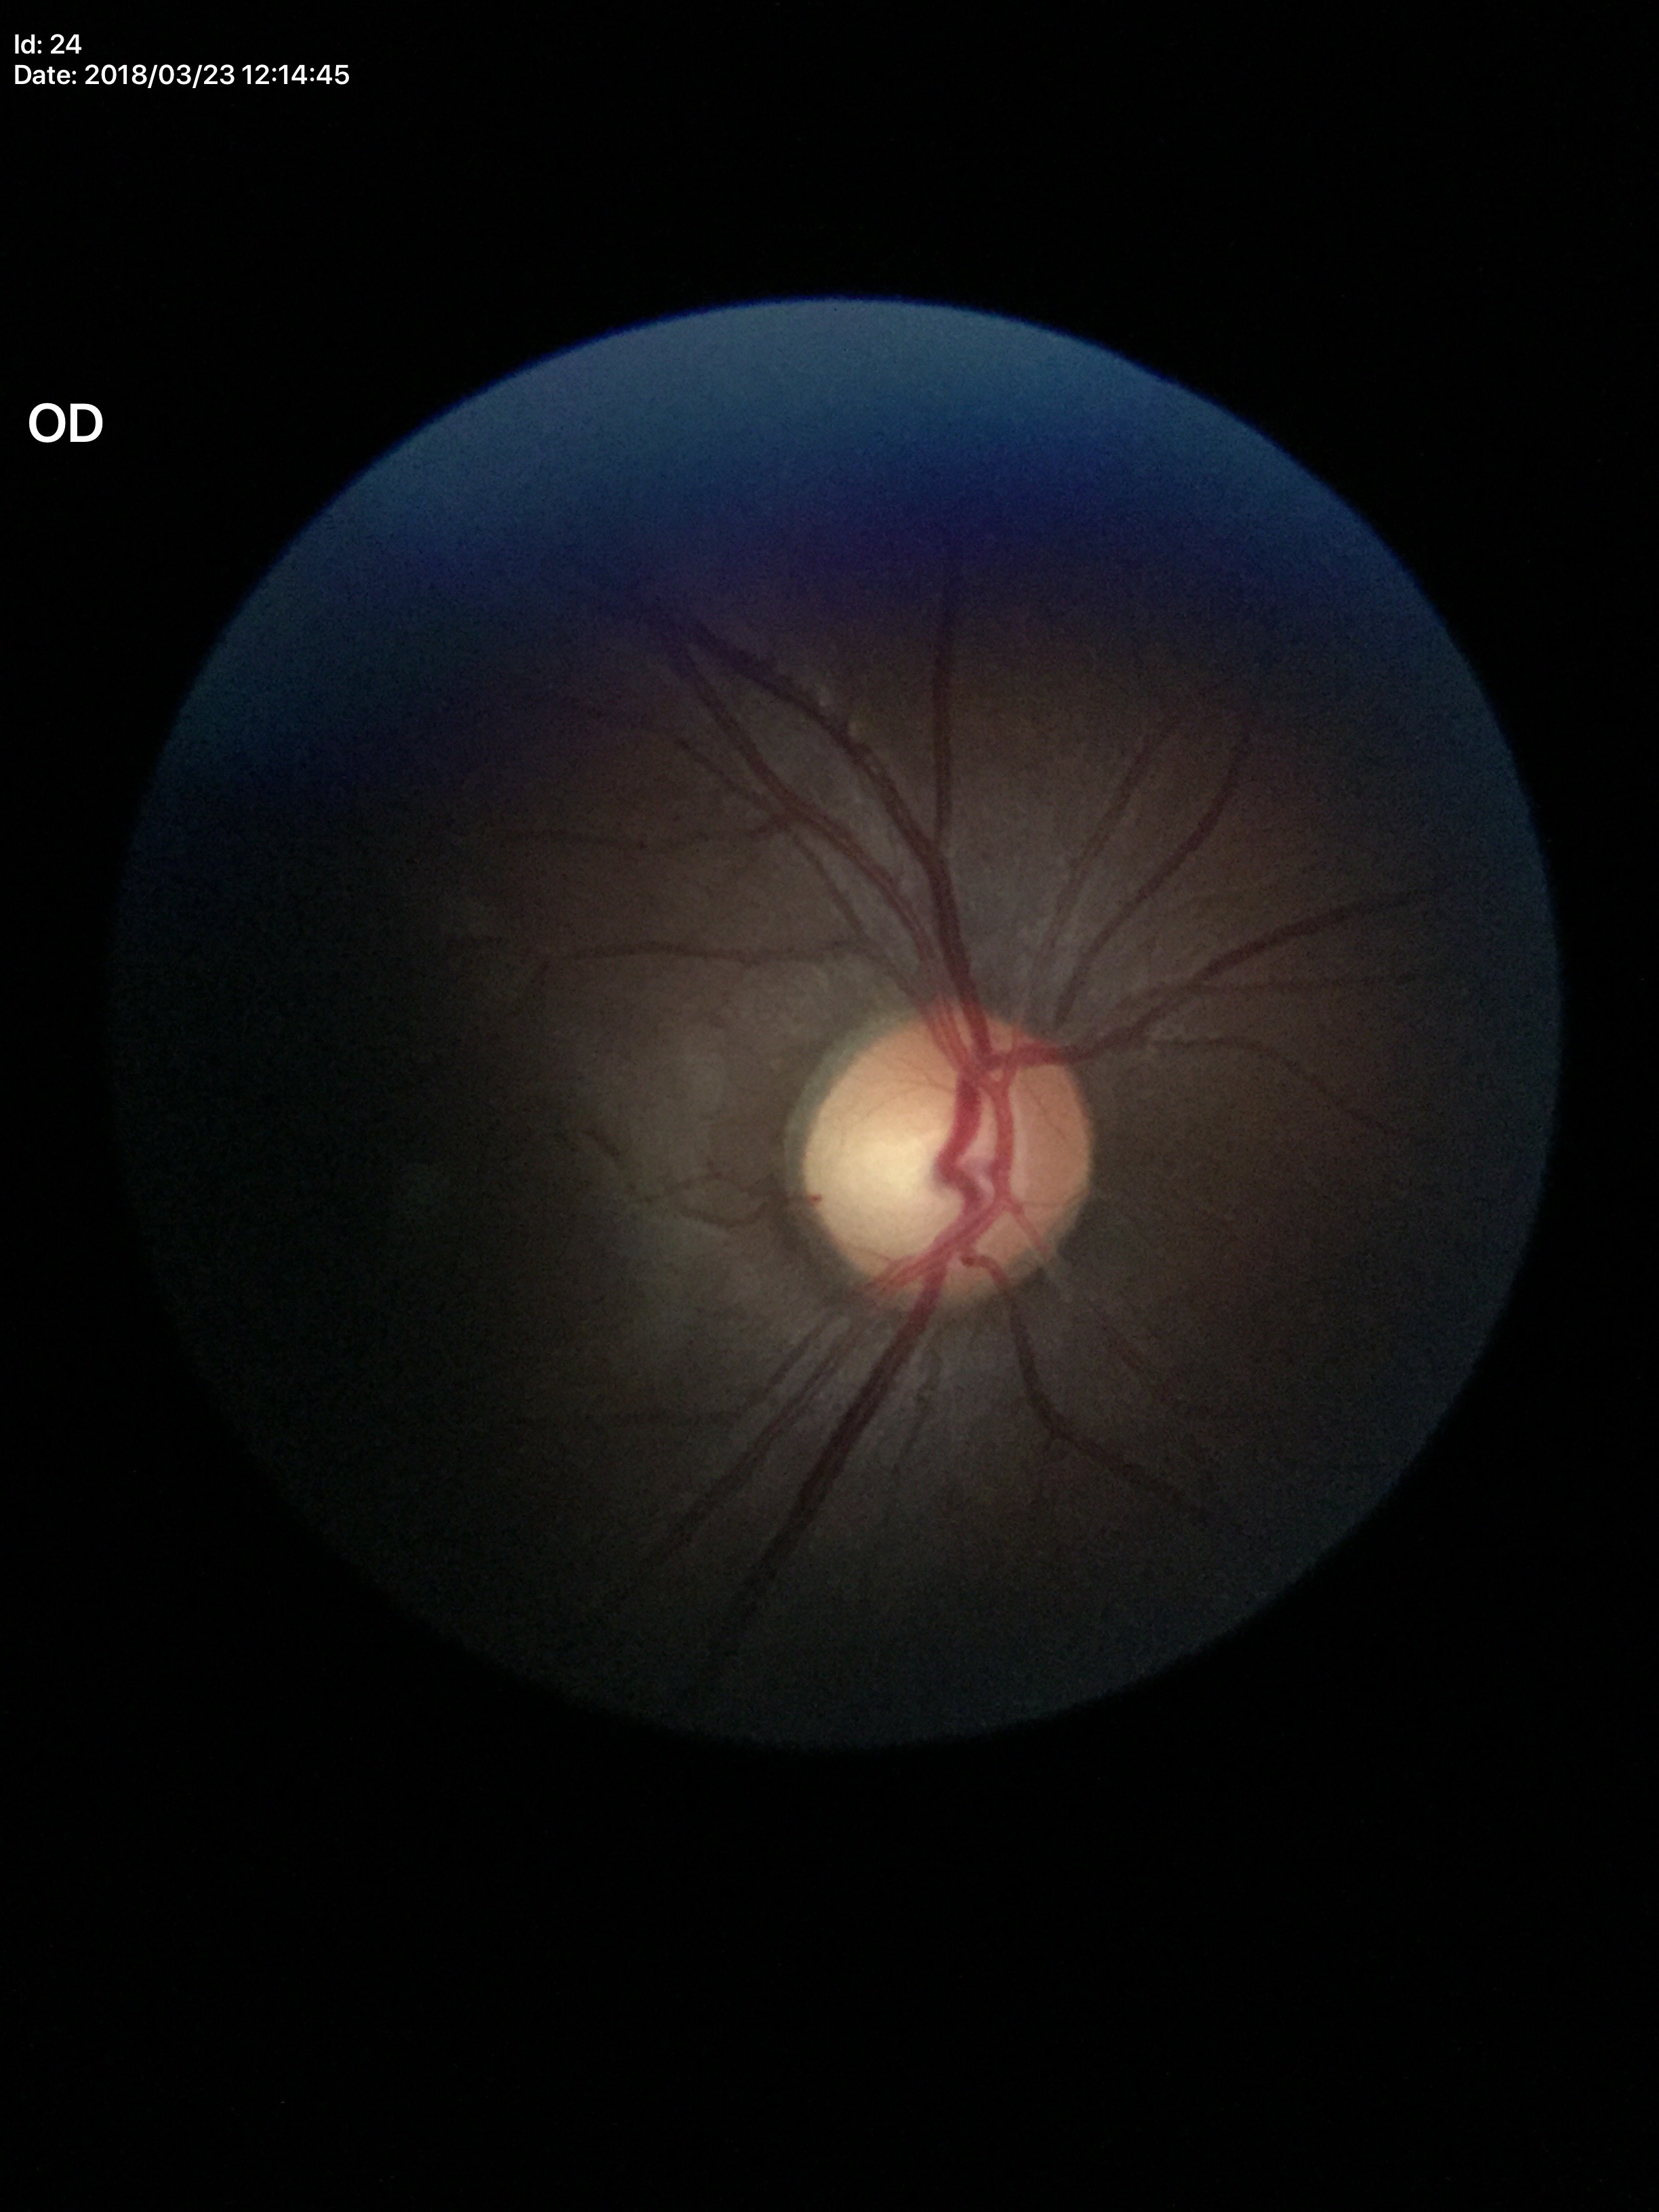

HCDR = 0.57; Glaucoma impression = suspicious findings; VCDR = 0.60.